Wide-field fundus photograph from neonatal ROP screening; camera: Clarity RetCam 3 (130° FOV); 640x480px: 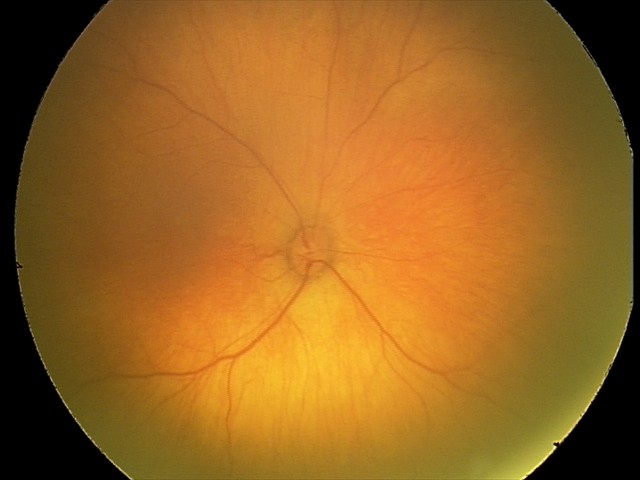

No retinal pathology identified on screening.